Acquired with a NIDEK AFC-230, nonmydriatic fundus photograph — 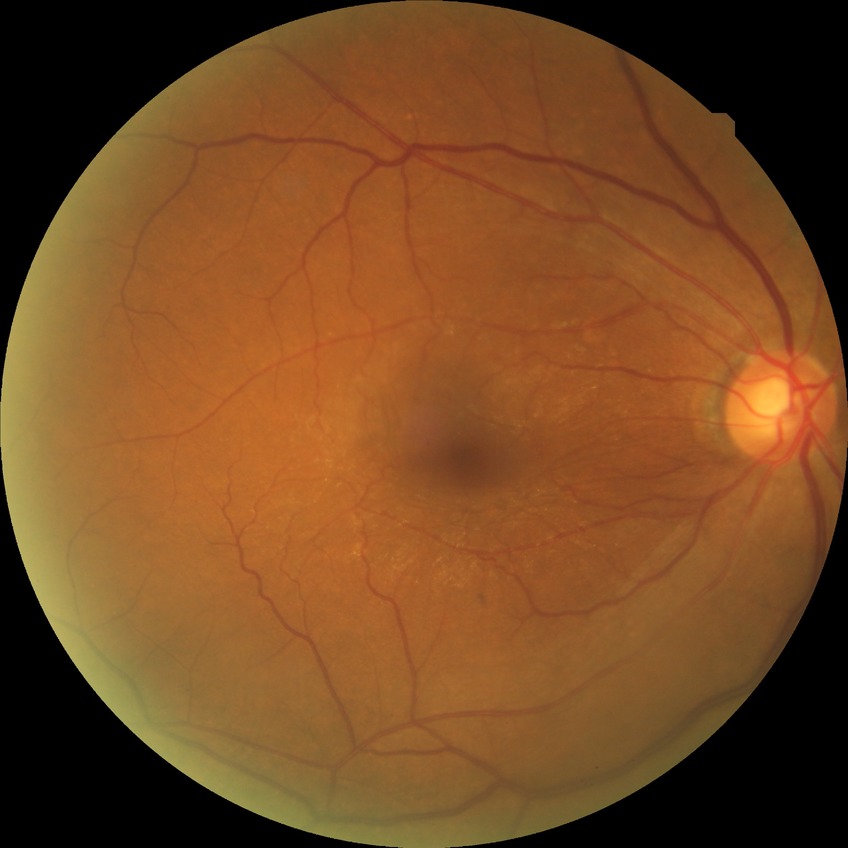

DR impression: no DR findings; Davis grade: NDR.